640 x 480 pixels. Infant wide-field fundus photograph:
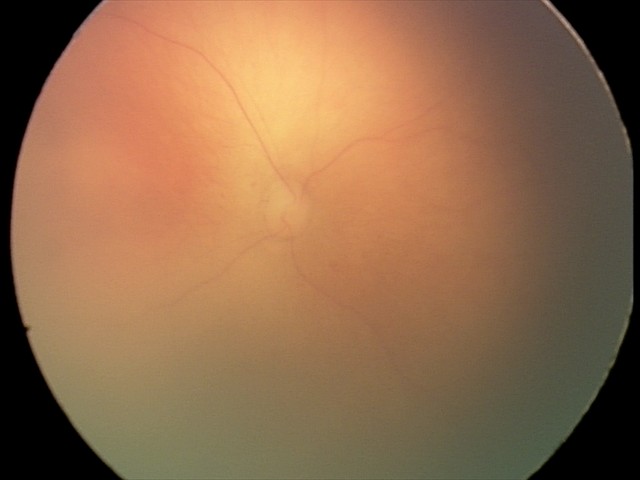 No plus disease. Screening examination consistent with retinopathy of prematurity stage 0 — incomplete retinal vascularization without a demarcation line.